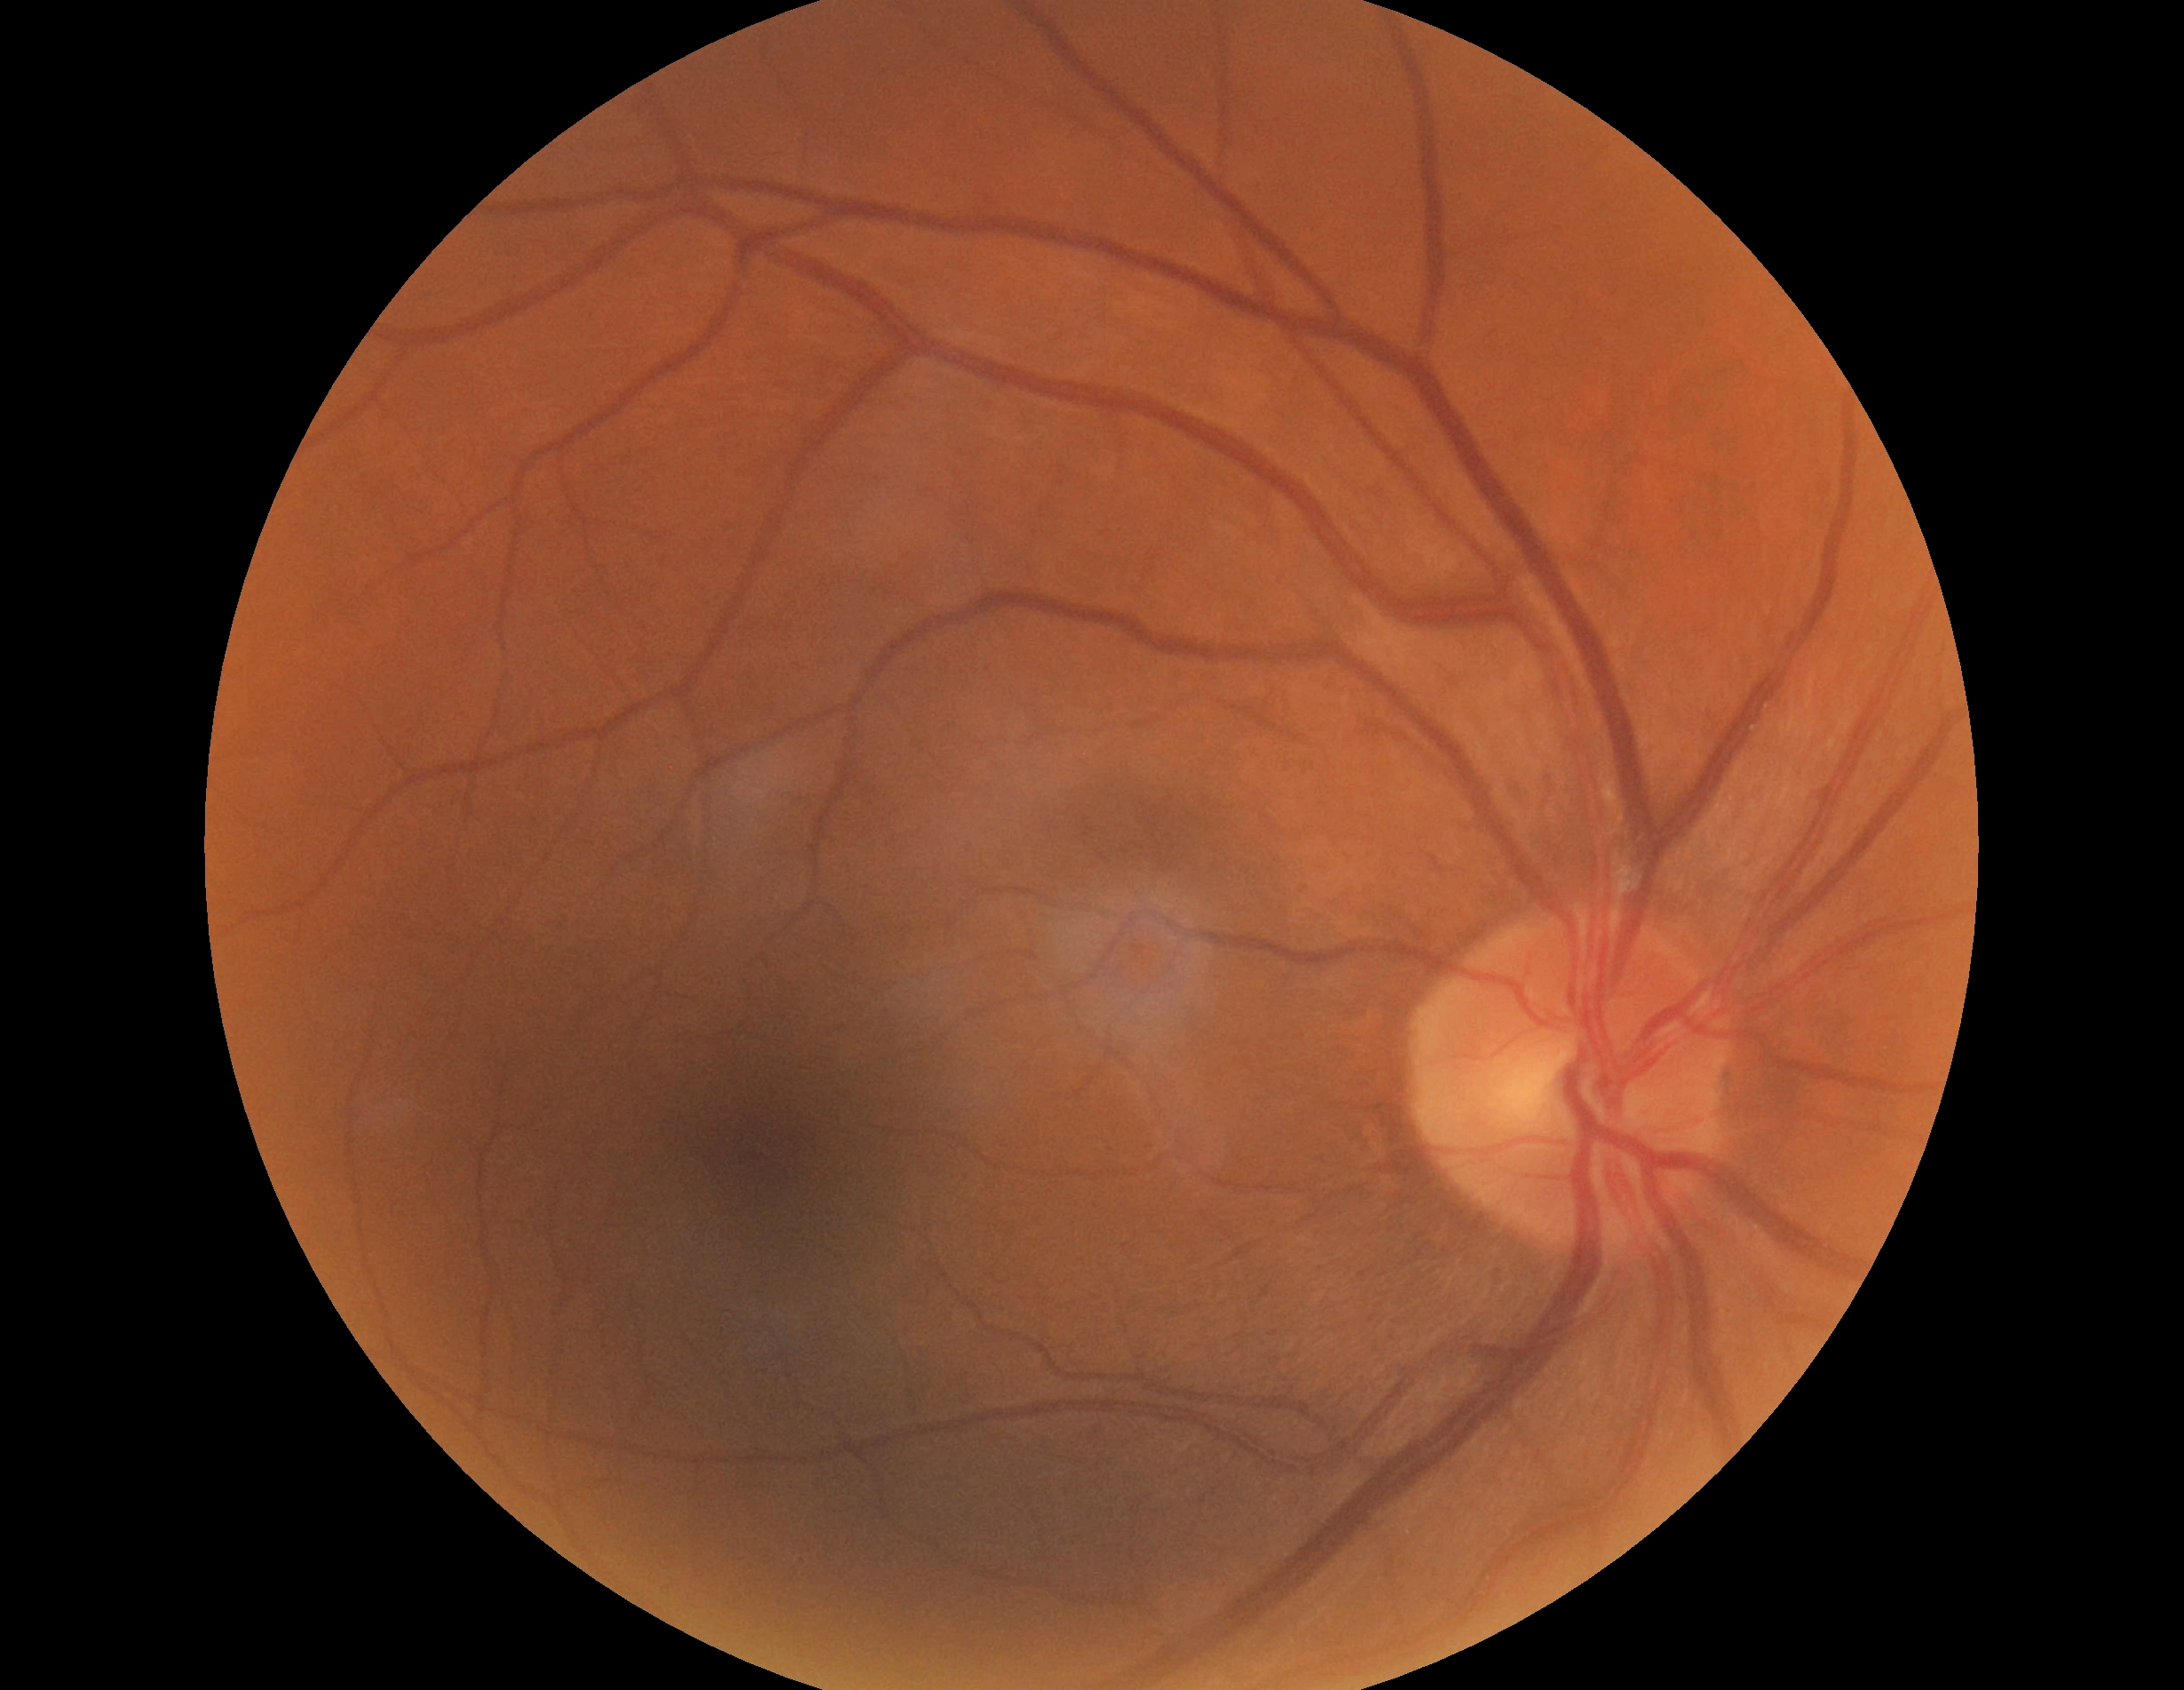

DR stage: 0/4.
No signs of diabetic retinopathy.